Retinal fundus photograph:
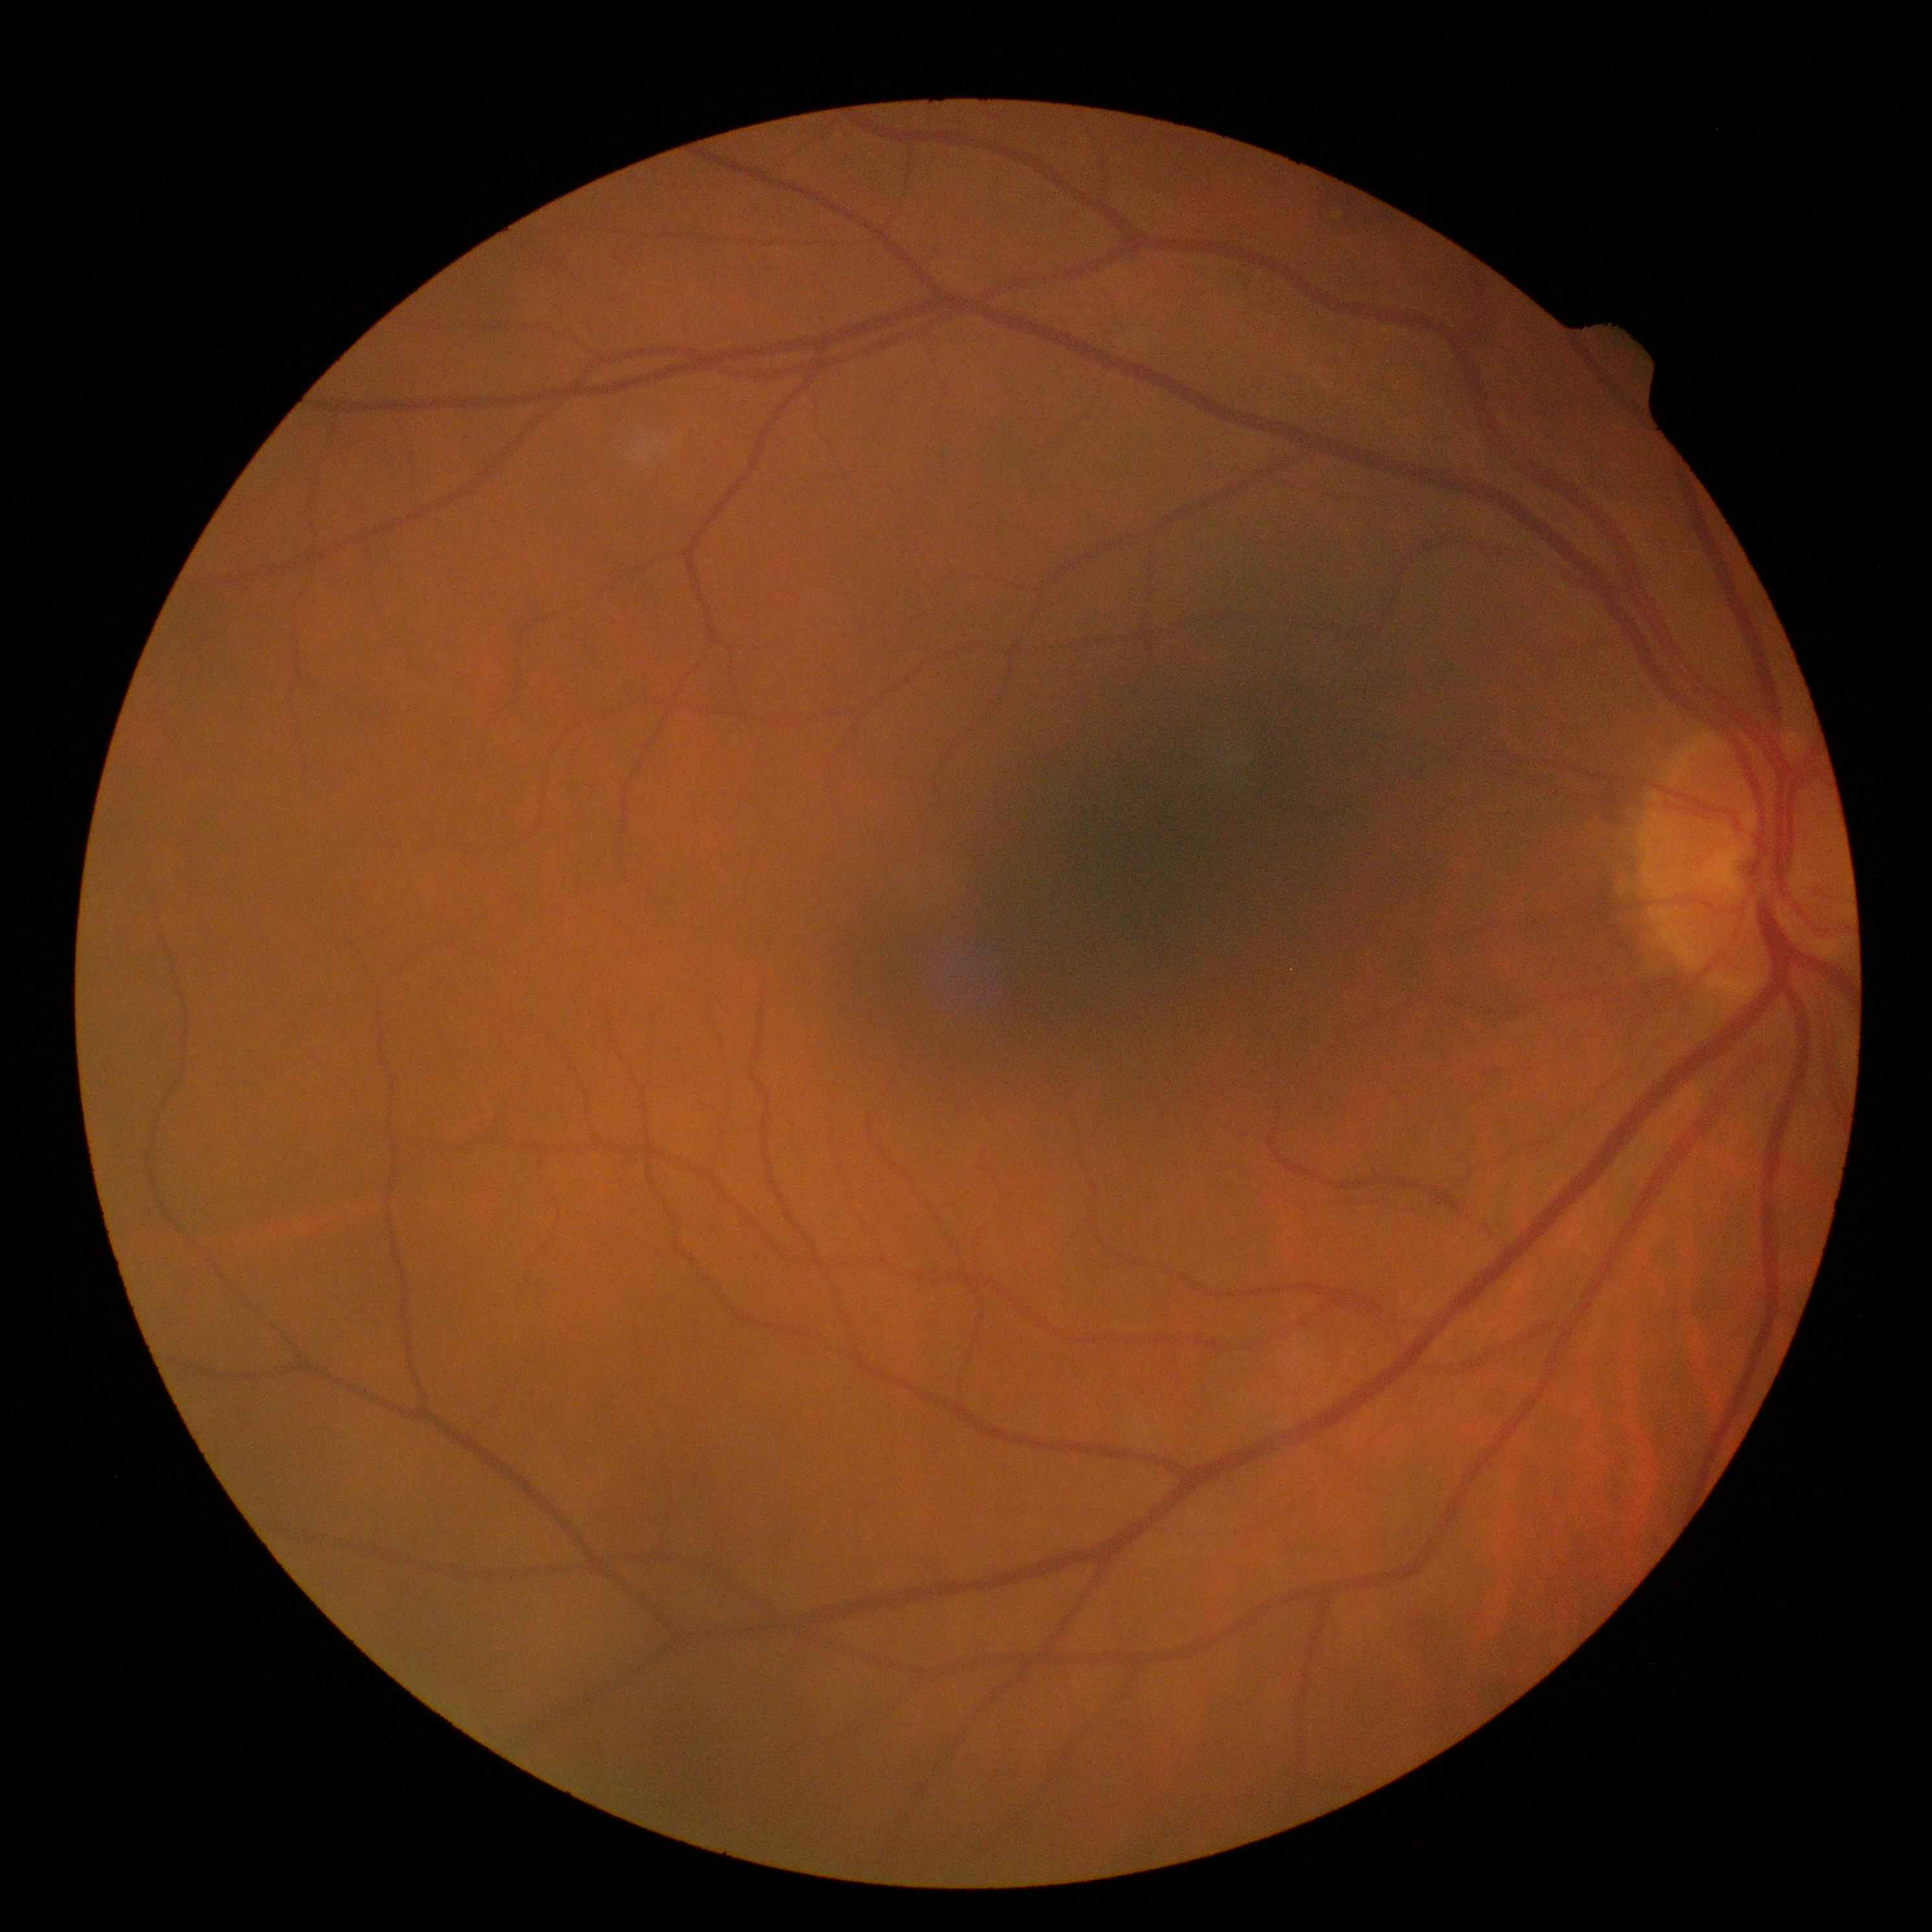
DR severity is 0.